Diabetic retinopathy graded by the modified Davis classification. 848x848px. FOV: 45 degrees. No pharmacologic dilation. Acquired with a NIDEK AFC-230:
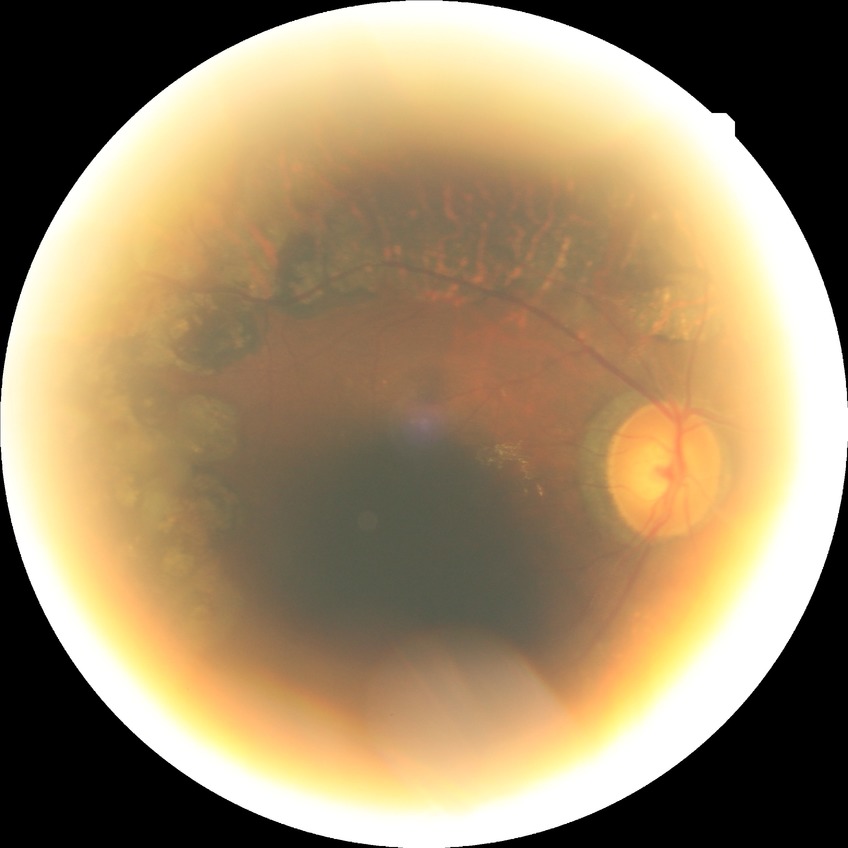

diabetic retinopathy stage=proliferative diabetic retinopathy.